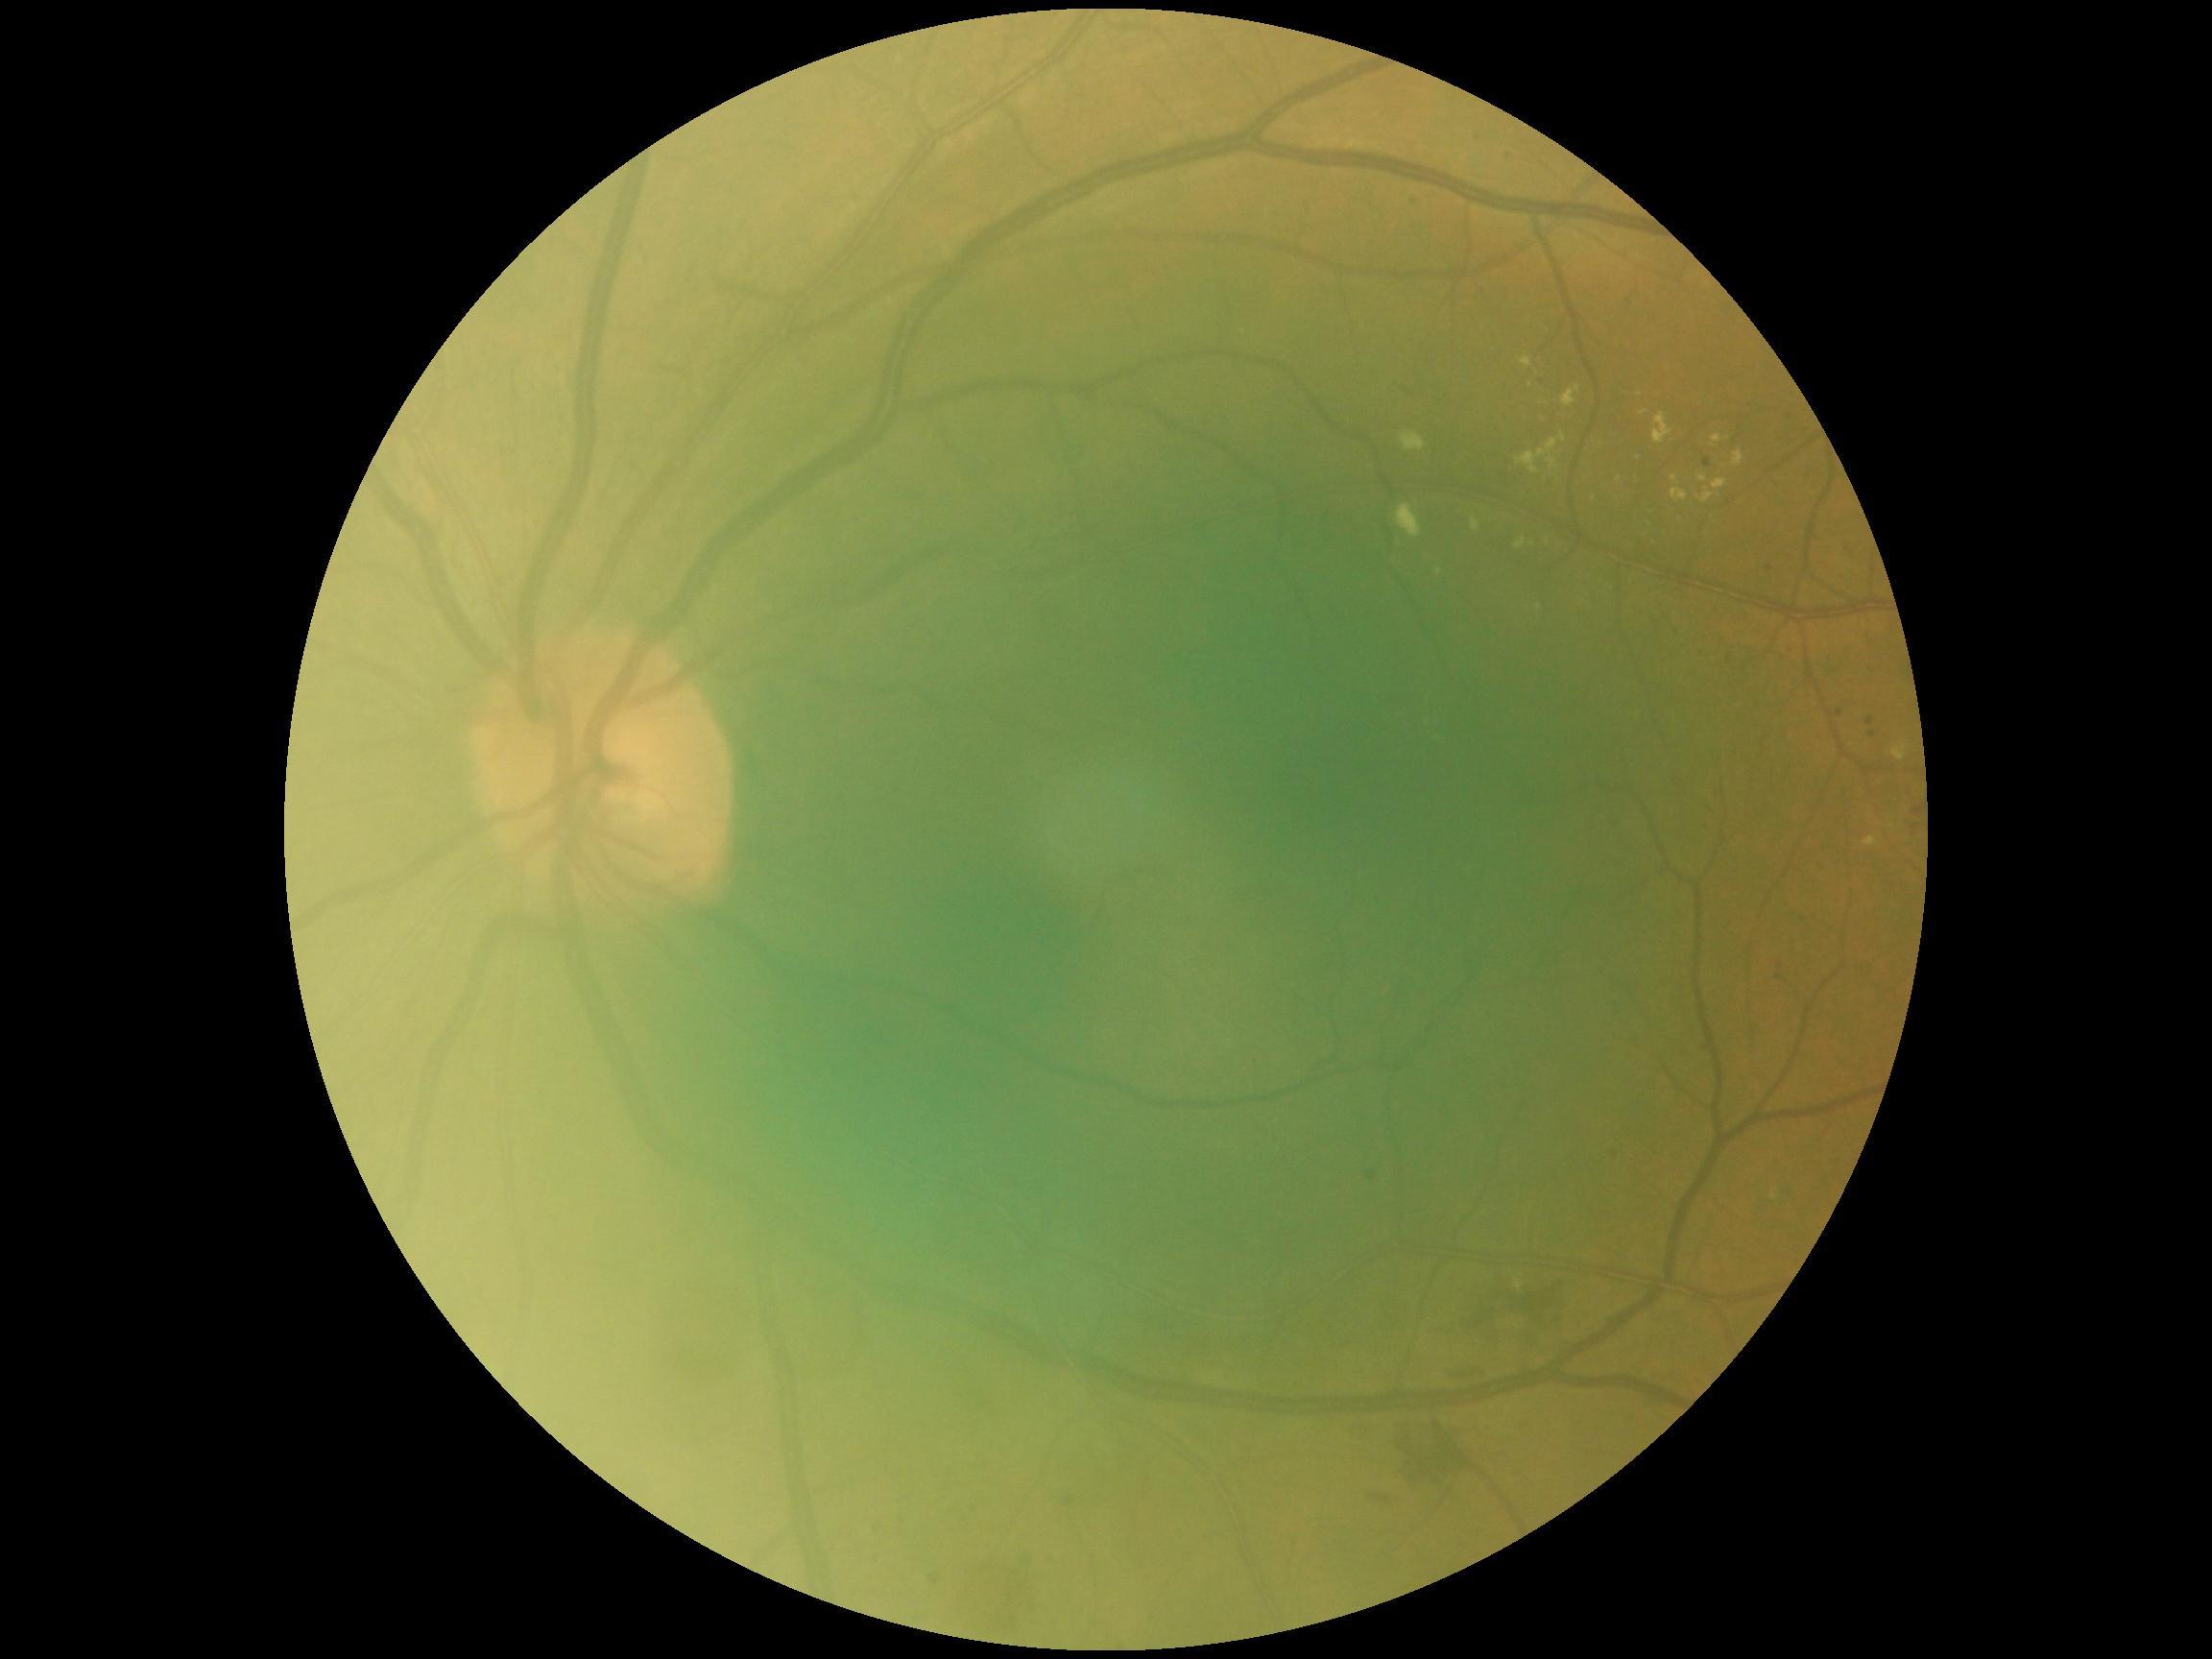
DR: grade 2 (moderate NPDR).